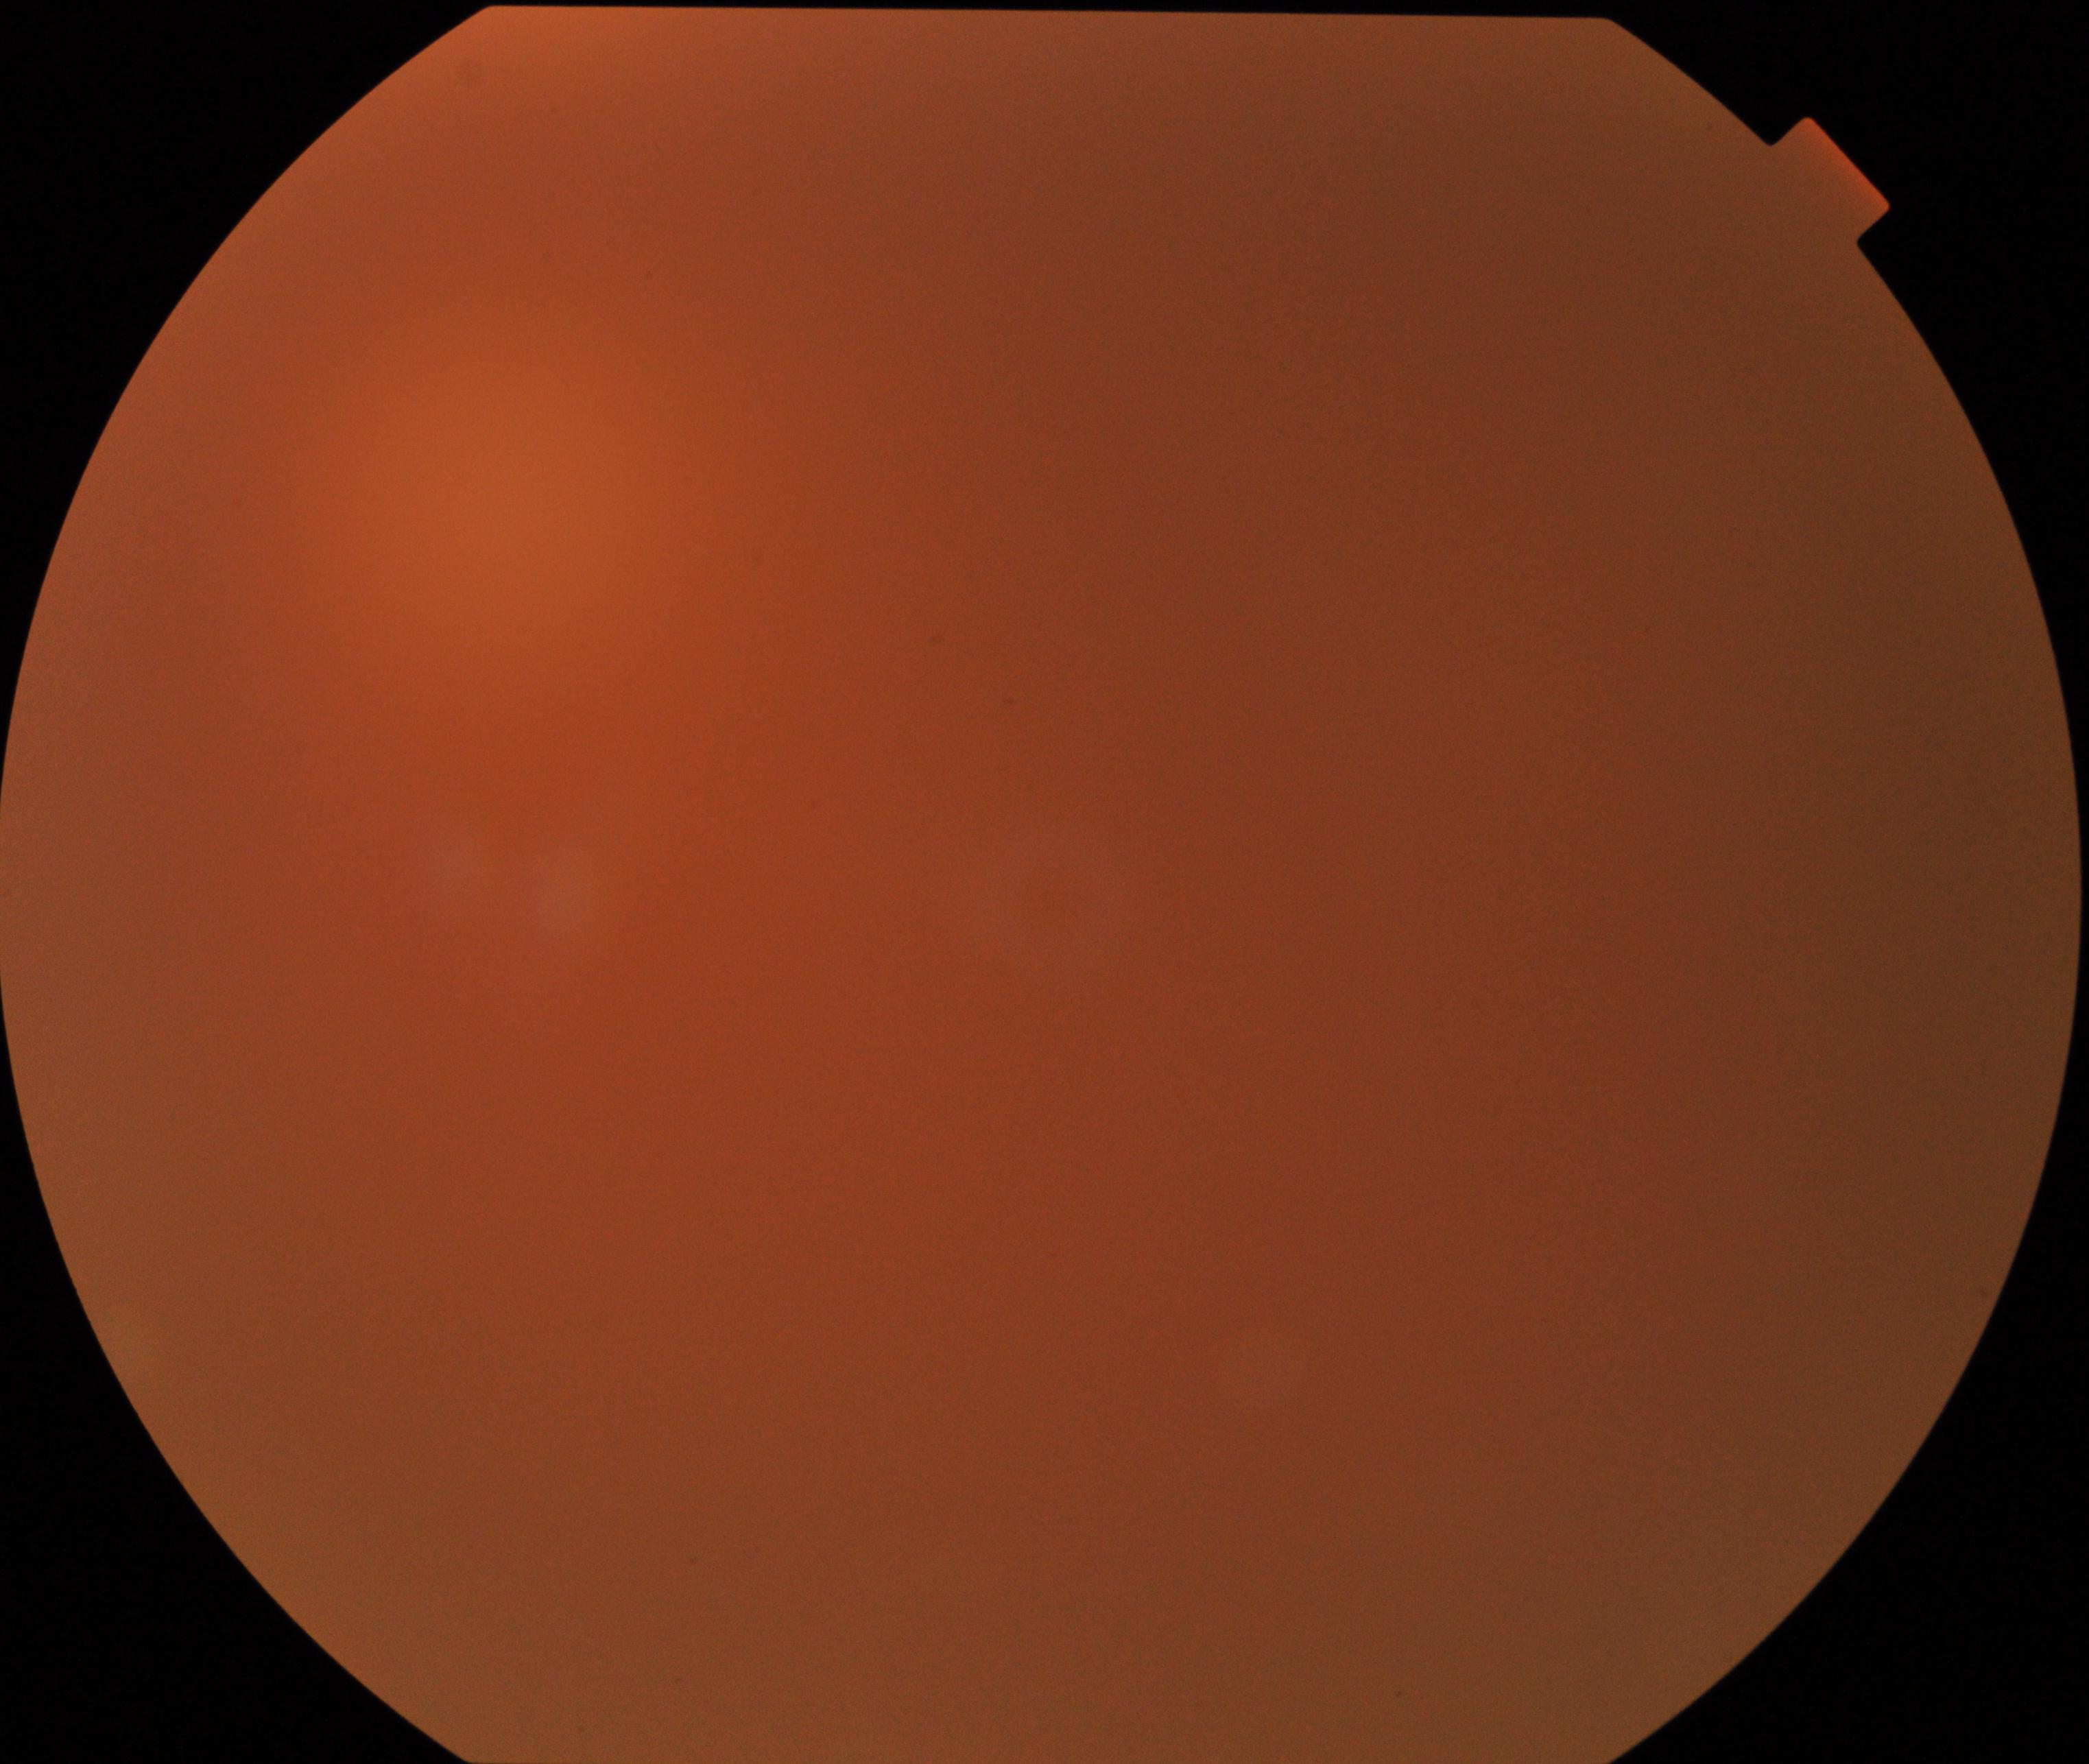

Image quality is poor; more than half the field is obscured. No evidence of proliferative diabetic retinopathy.